1240x1240px; wide-field contact fundus photograph of an infant
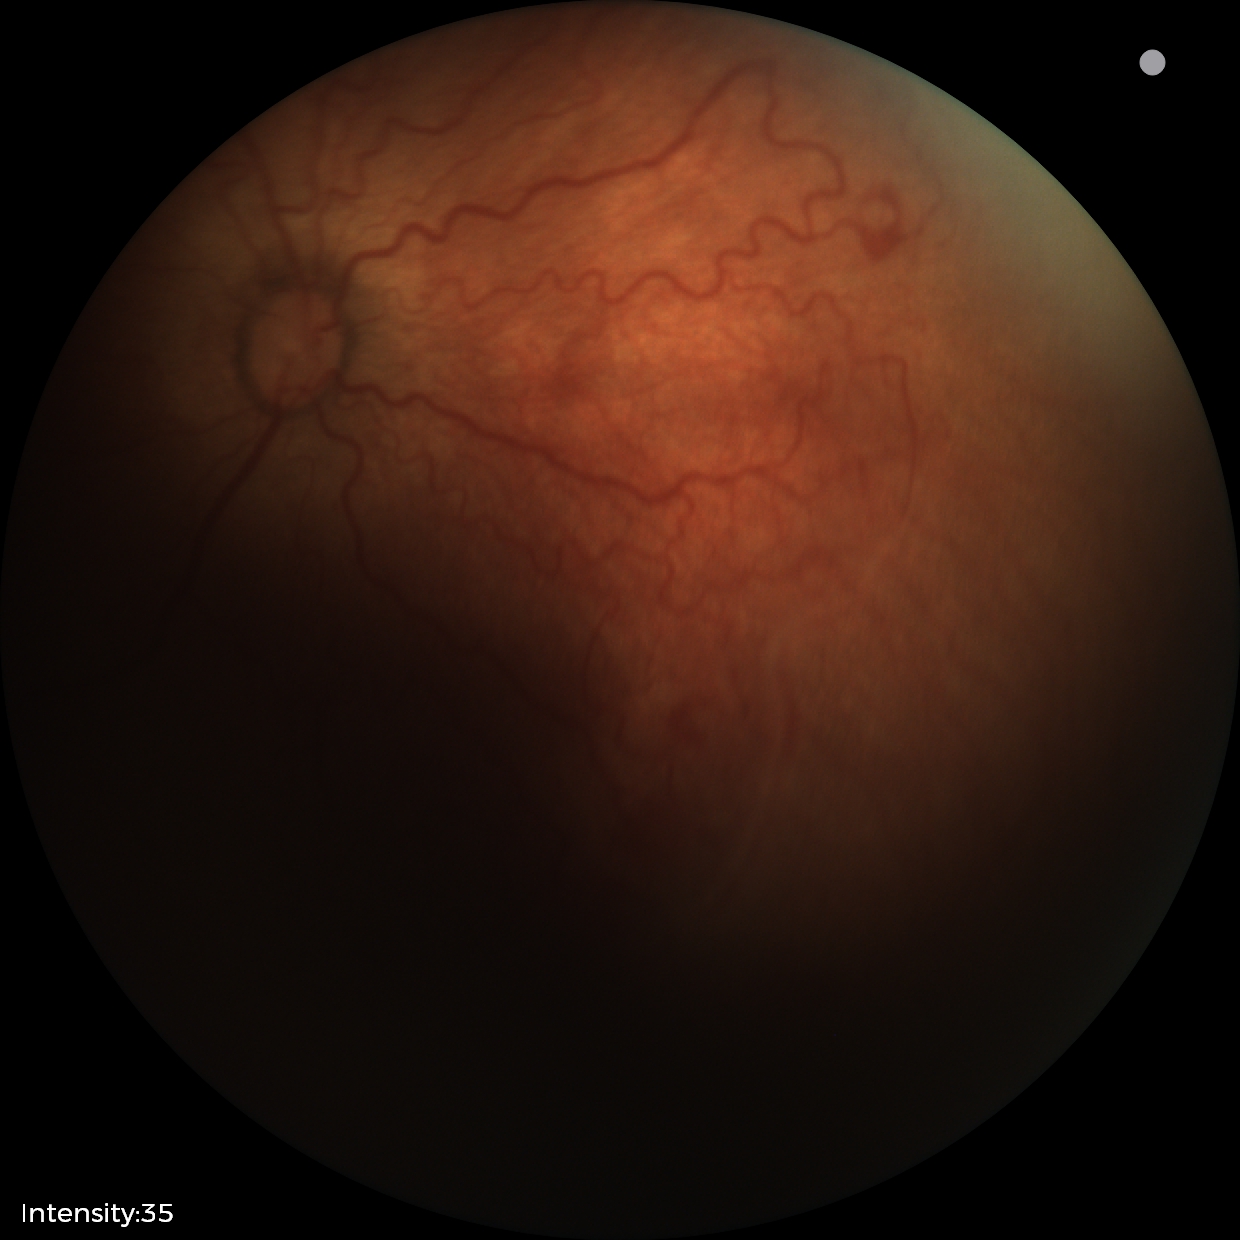 From an examination with diagnosis of ROP stage 2 — ridge with height and width at the demarcation line.
Plus disease was diagnosed.